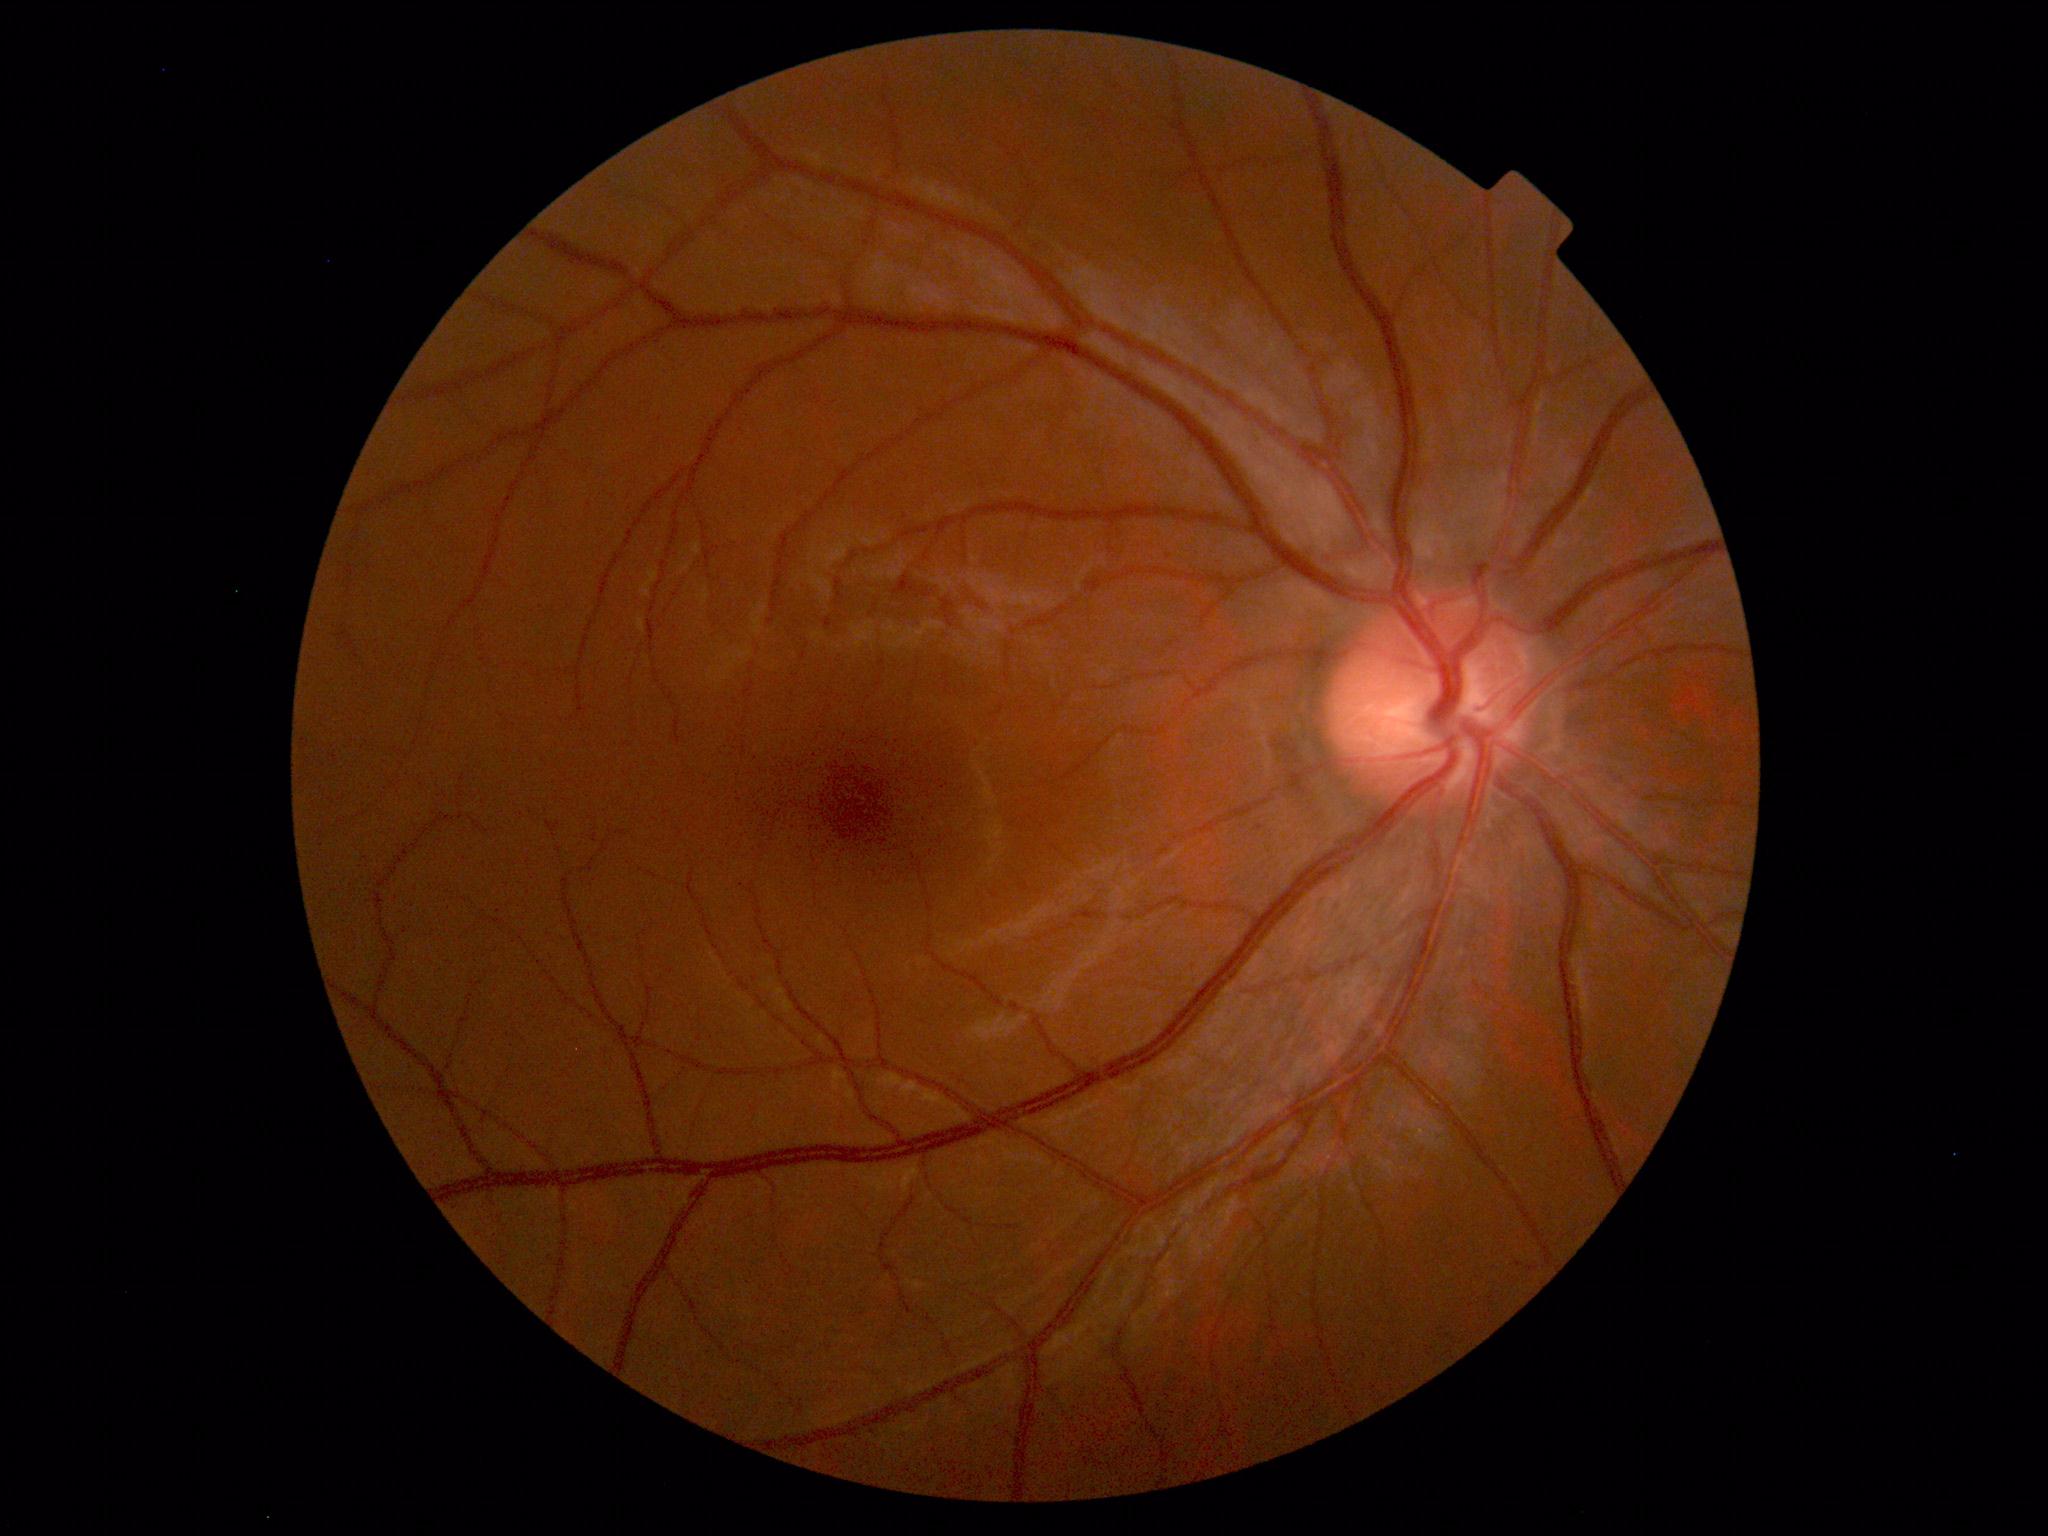 Findings: no abnormalities.